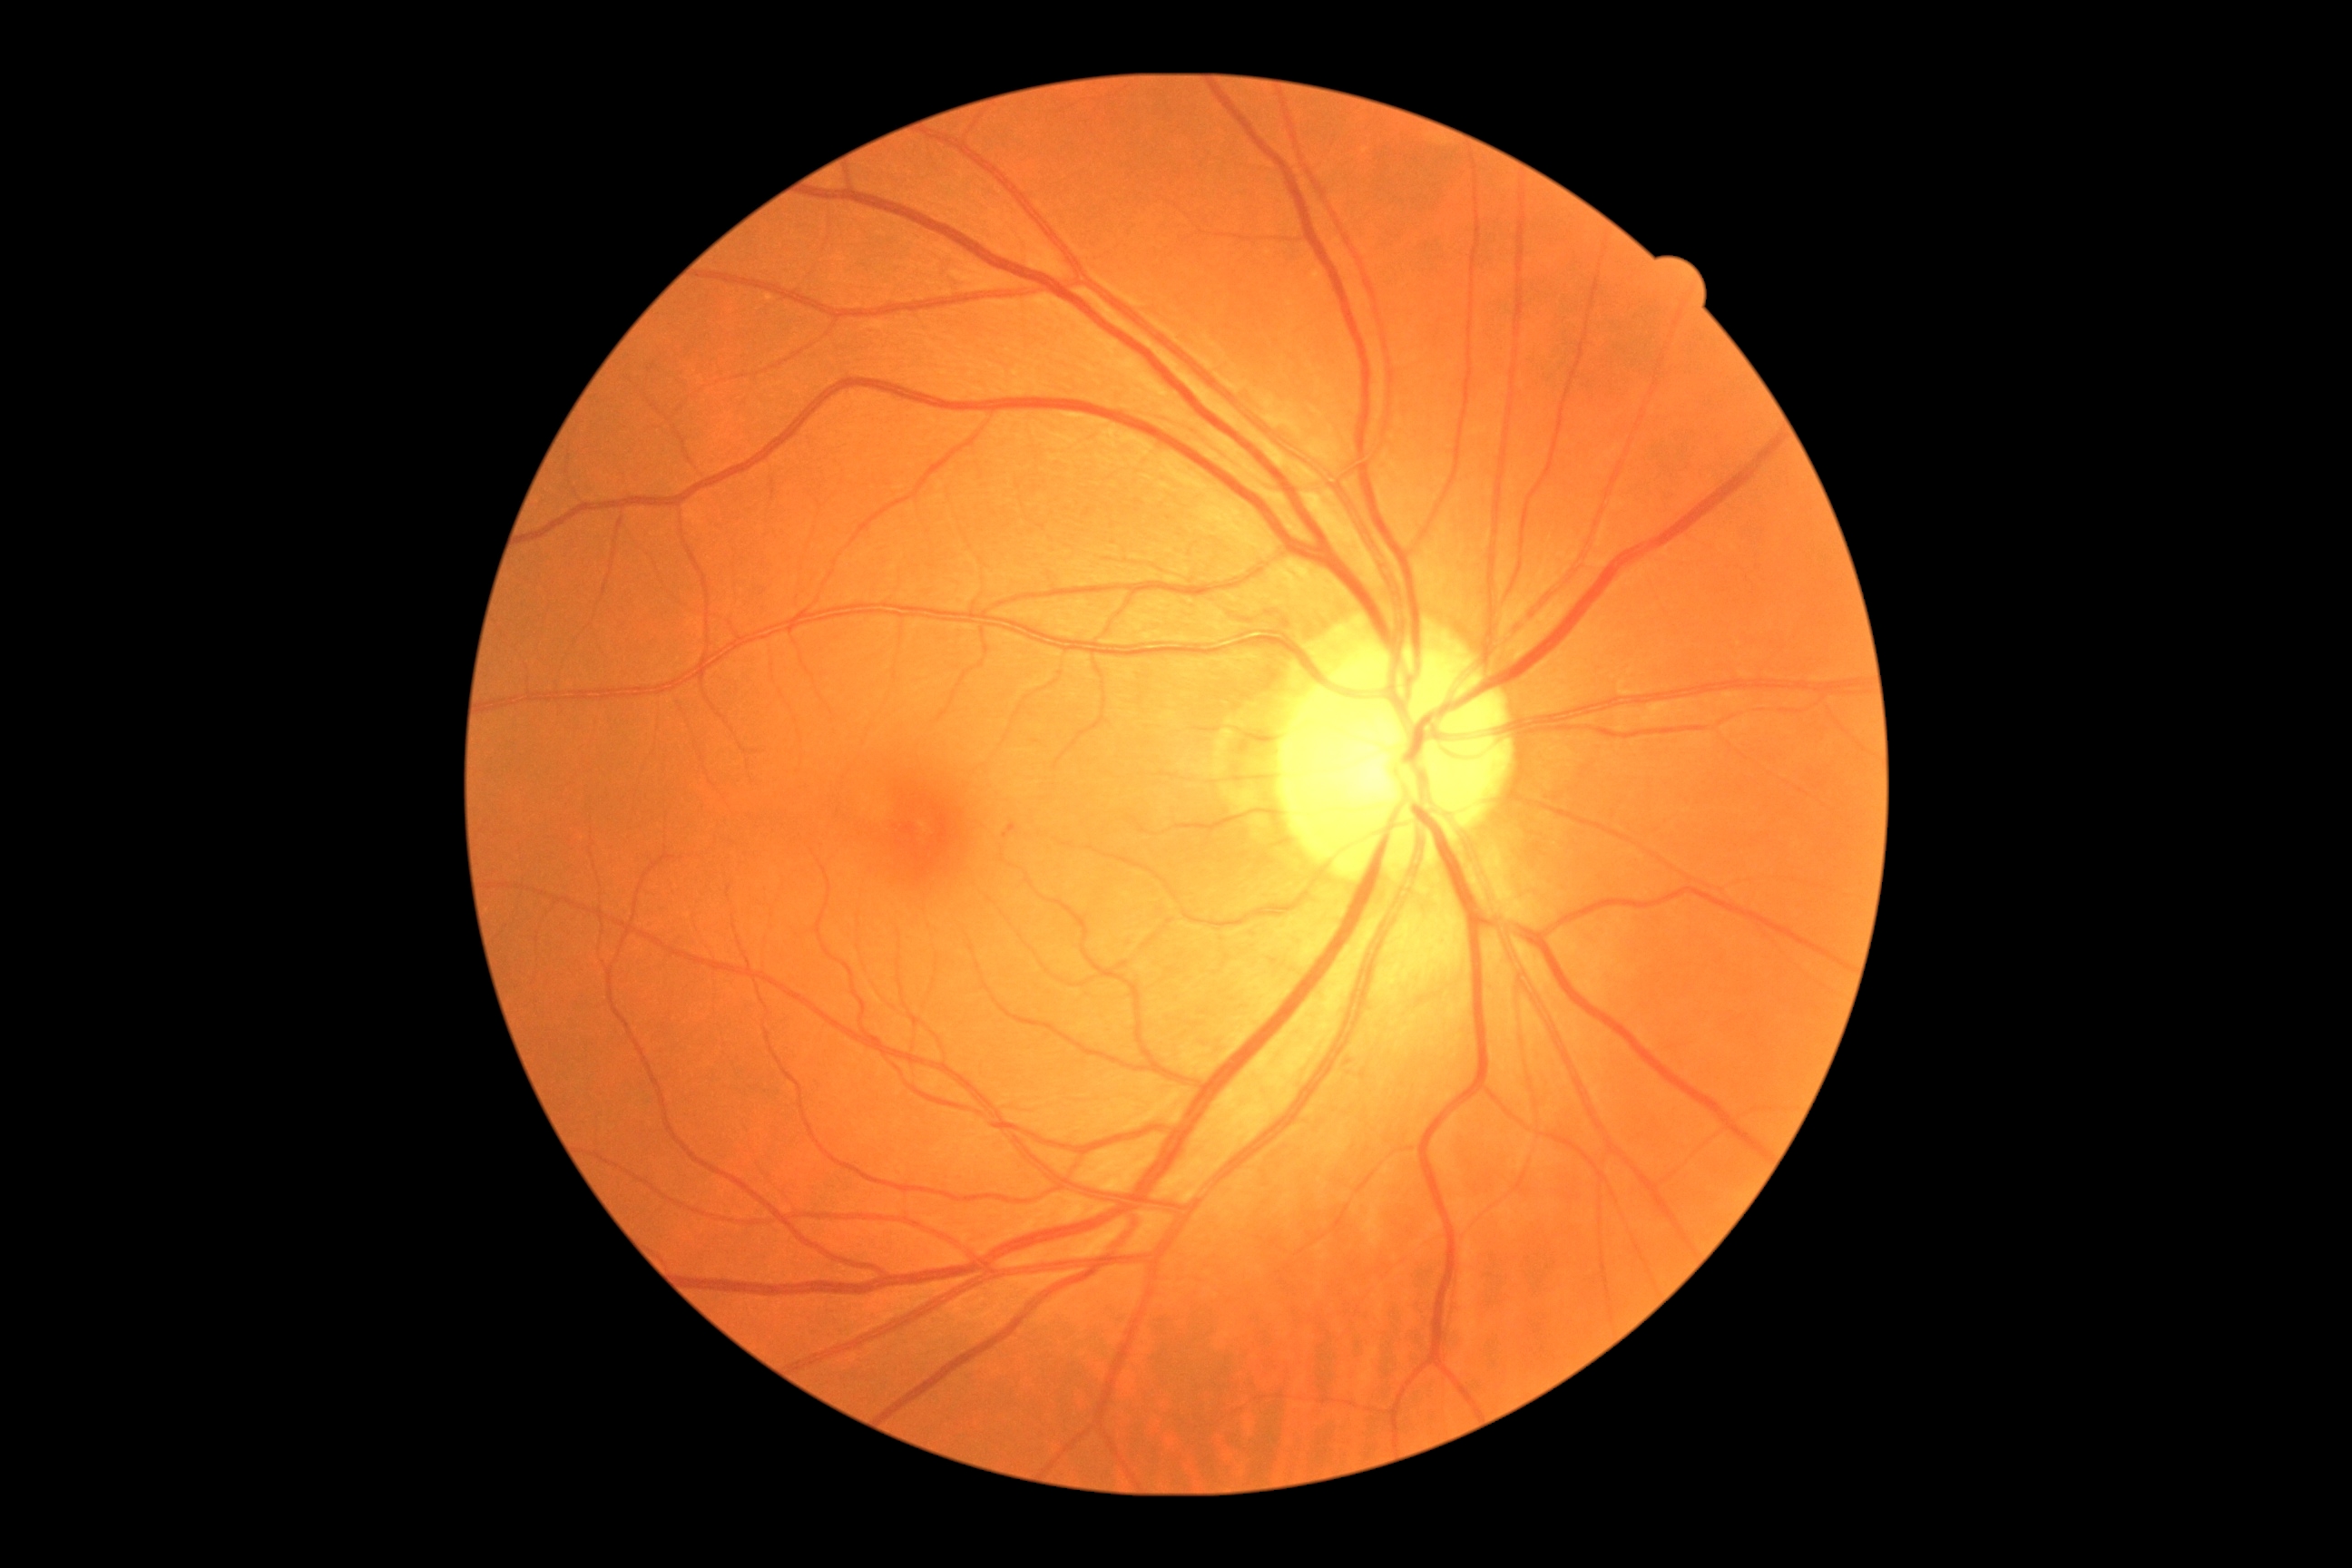 diabetic retinopathy = 1/4